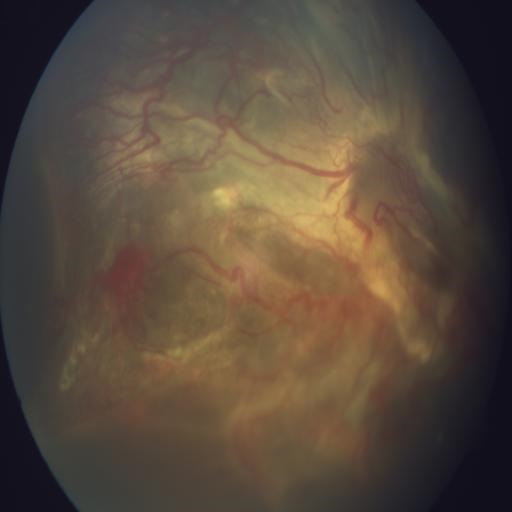
Retinal fundus photograph demonstrating retinitis (RS).